Fundus photo, acquired with a Nidek AFC-330, disc-centered field
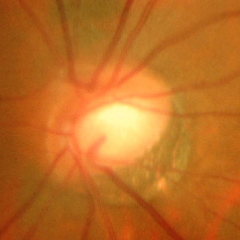 Q: Glaucoma assessment?
A: Yes — severe glaucomatous damage.